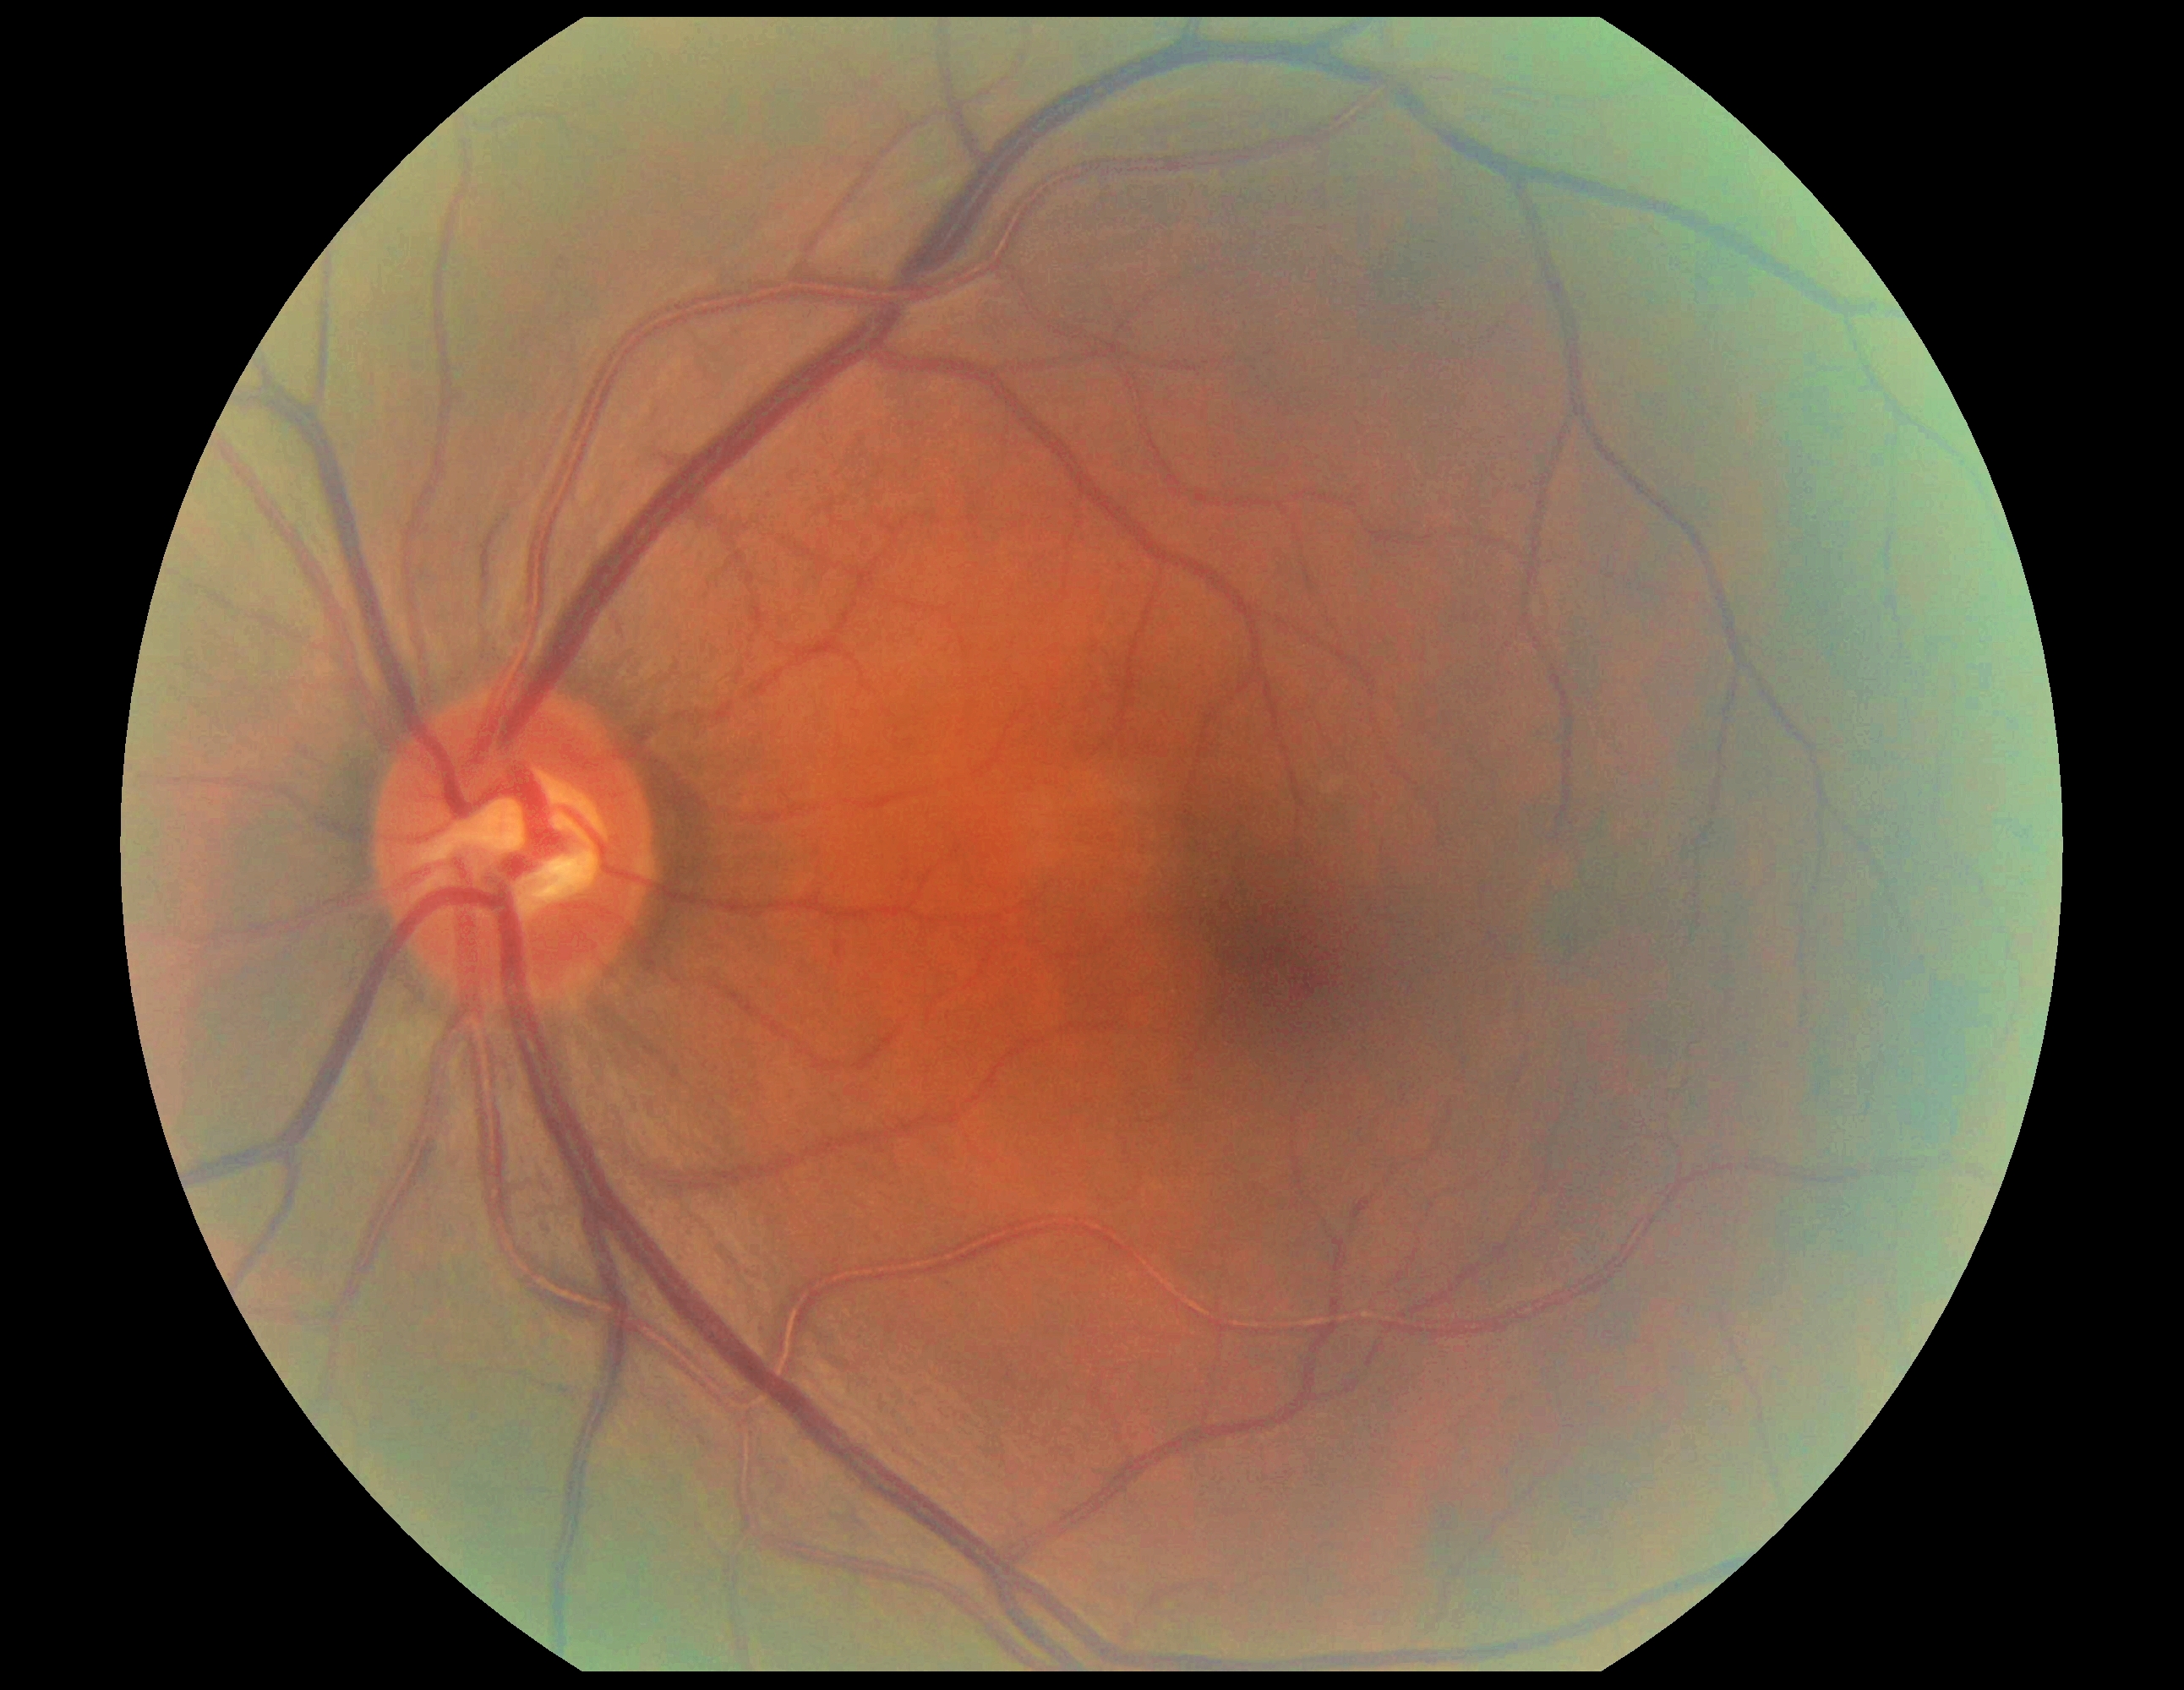
No diabetic retinal disease findings.
DR grade is 0/4.